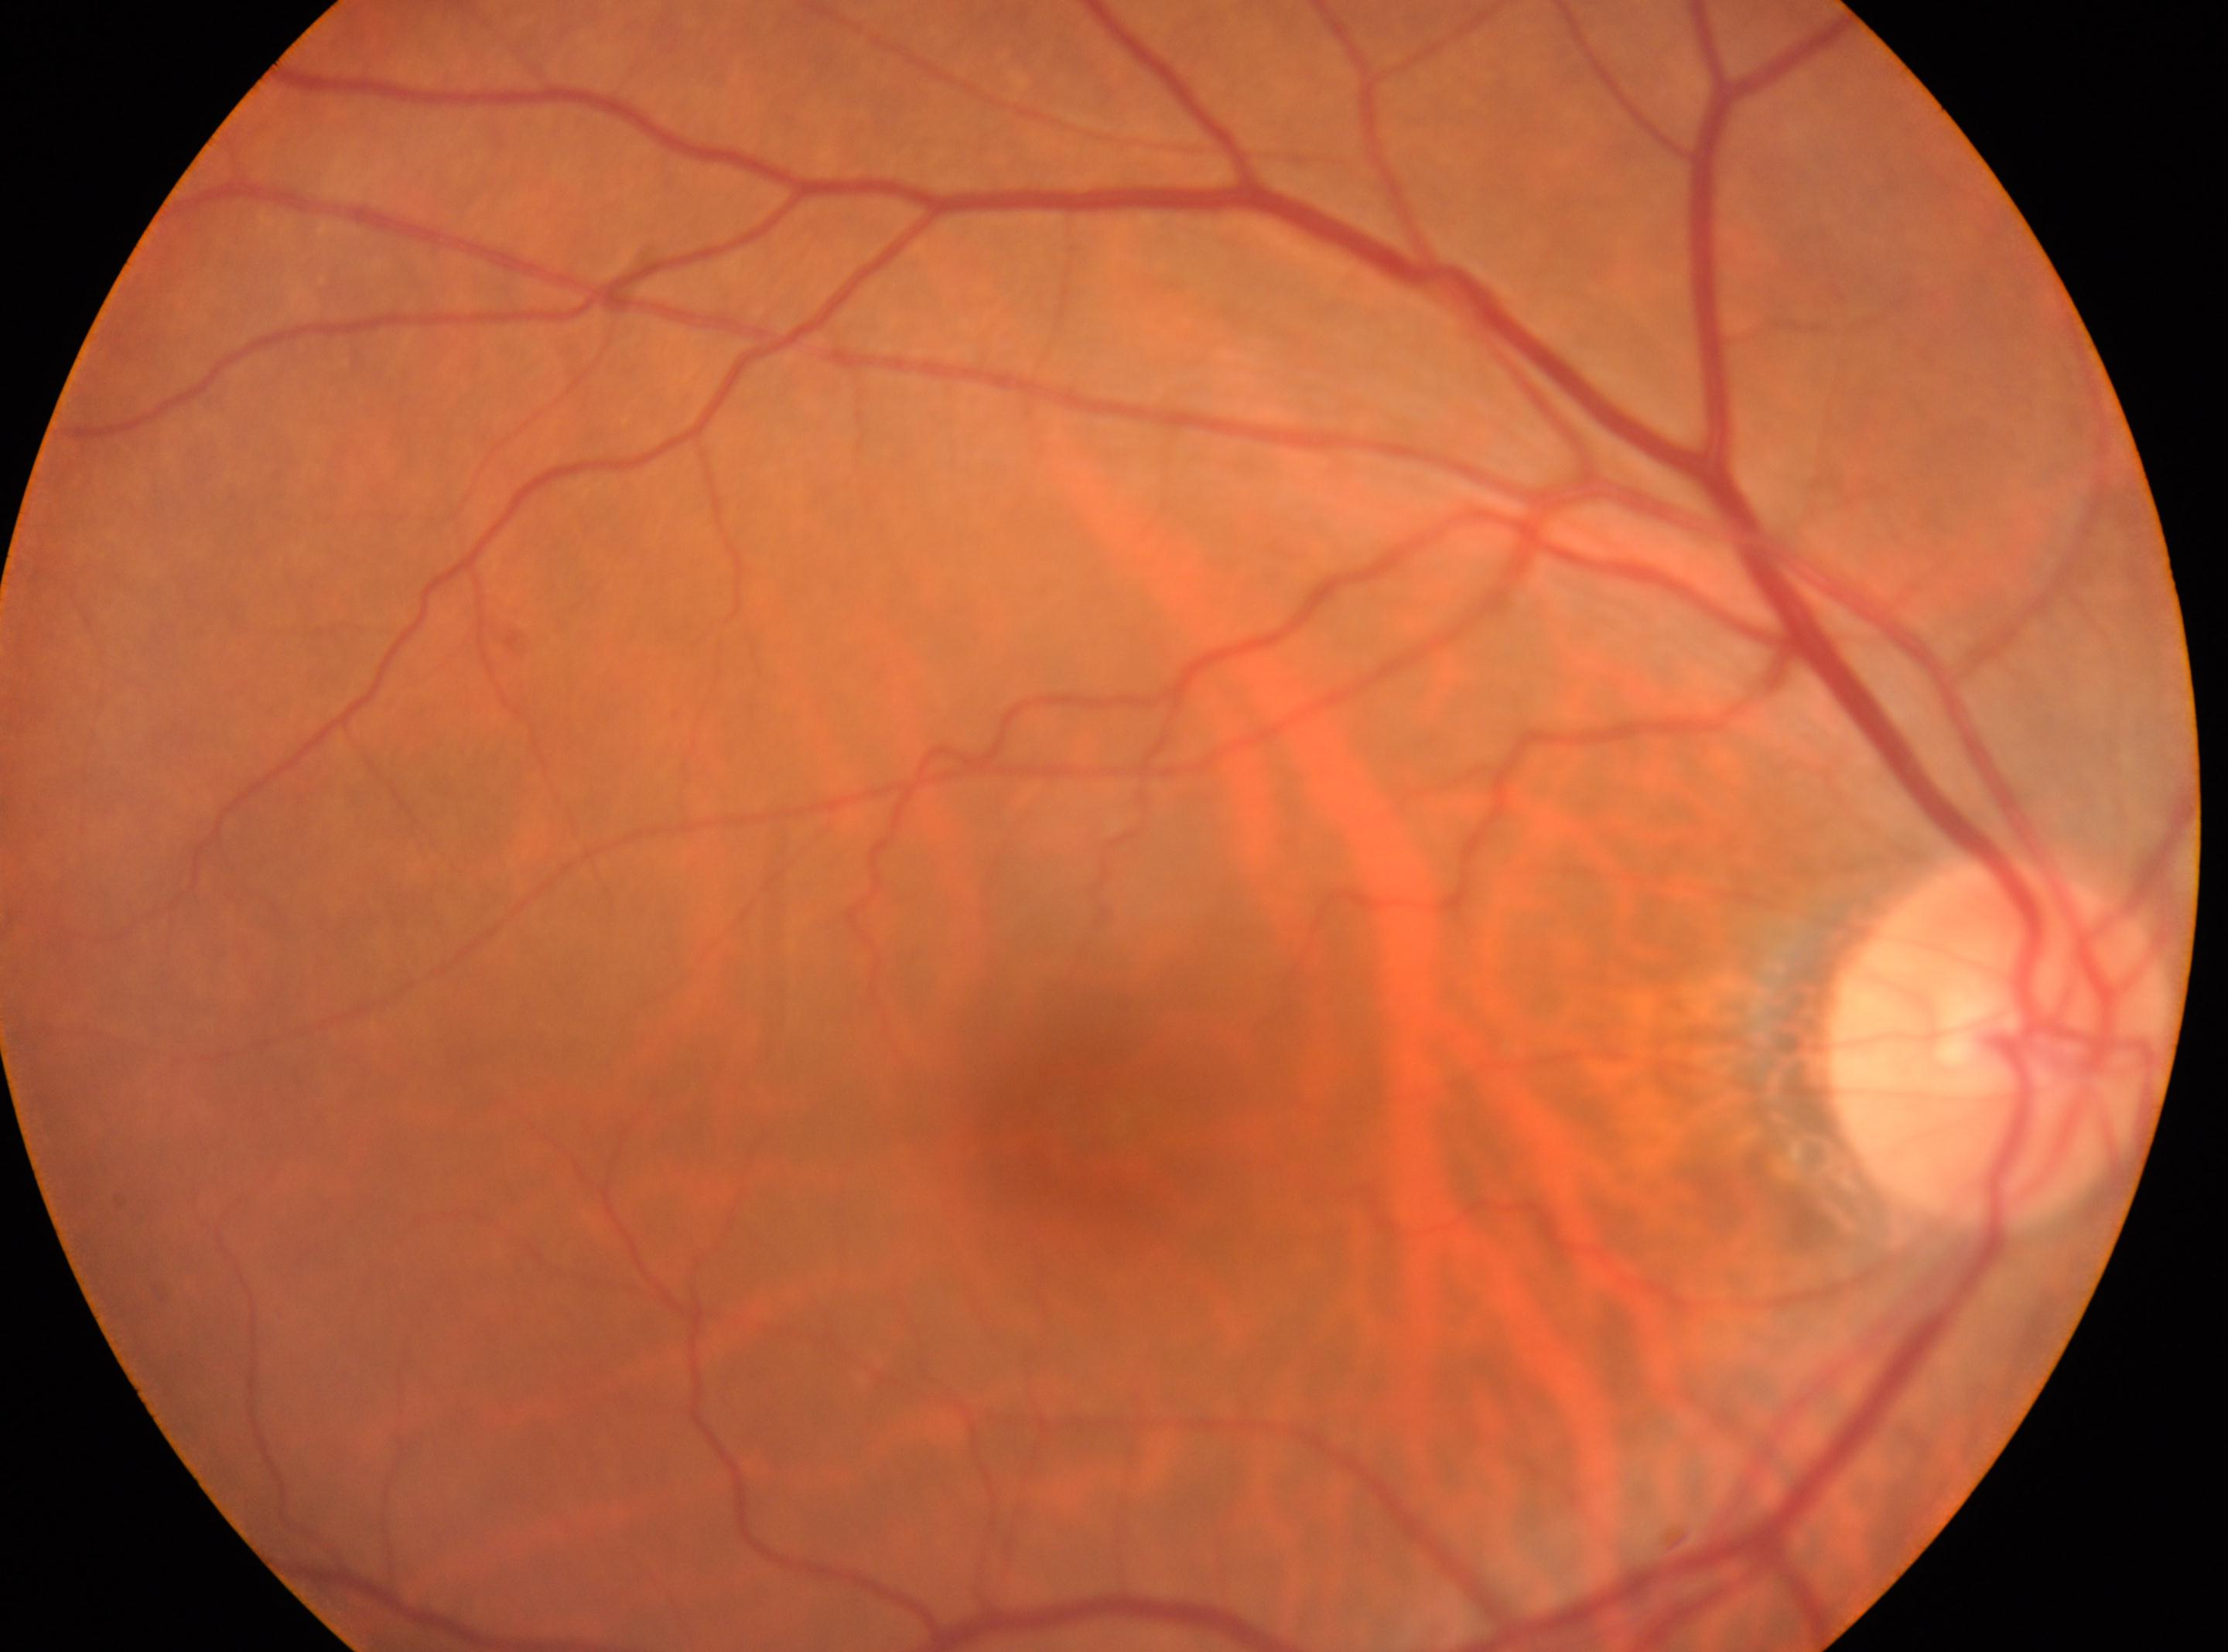

  fovea: 1063px, 1117px
  dr_impression: No signs of diabetic retinopathy
  eye: the right eye
  optic_disc: 1998px, 1044px
  dr_grade: 0 (no apparent retinopathy)